No pharmacologic dilation · retinal fundus photograph:
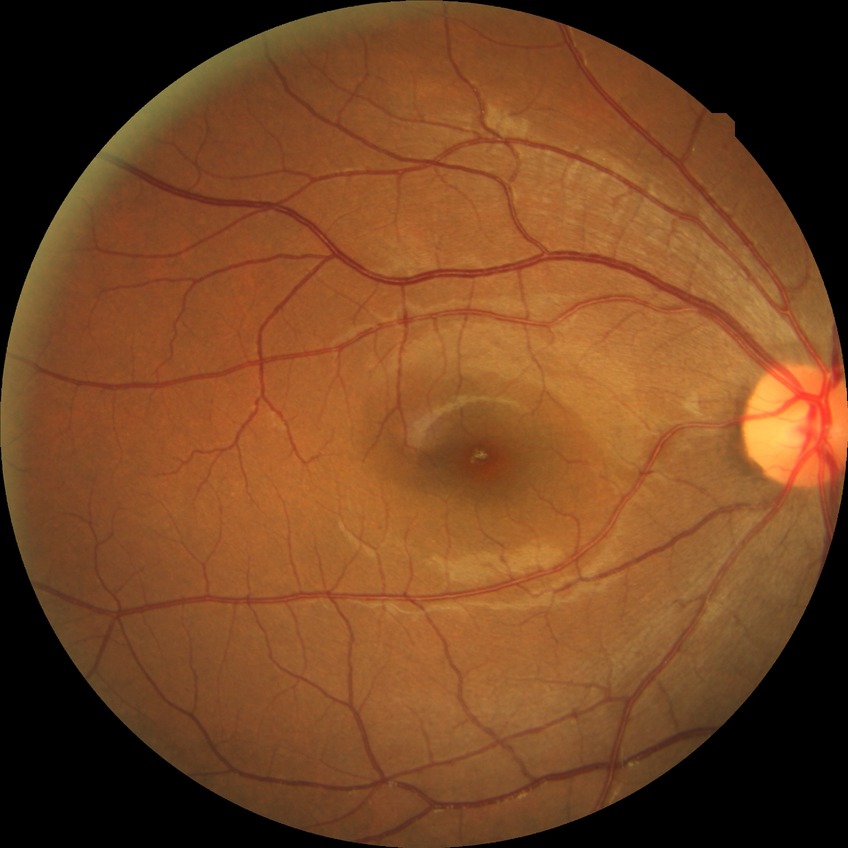 {
  "davis_grade": "no diabetic retinopathy"
}